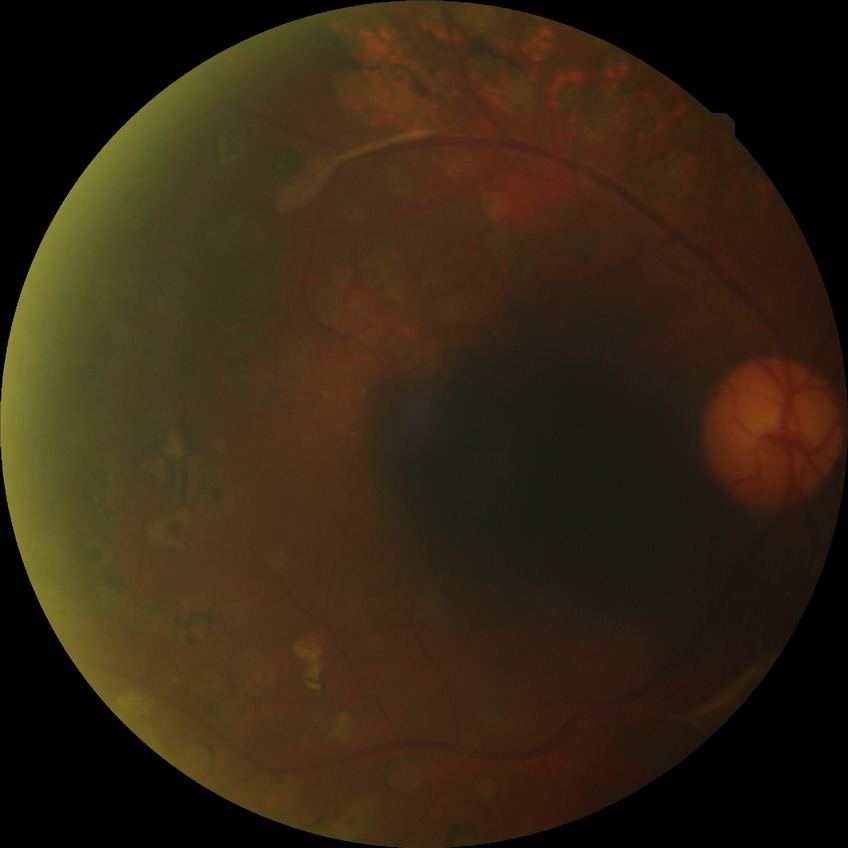

Assessment:
• retinopathy stage — proliferative diabetic retinopathy